Nonmydriatic fundus photograph. NIDEK AFC-230. CFP
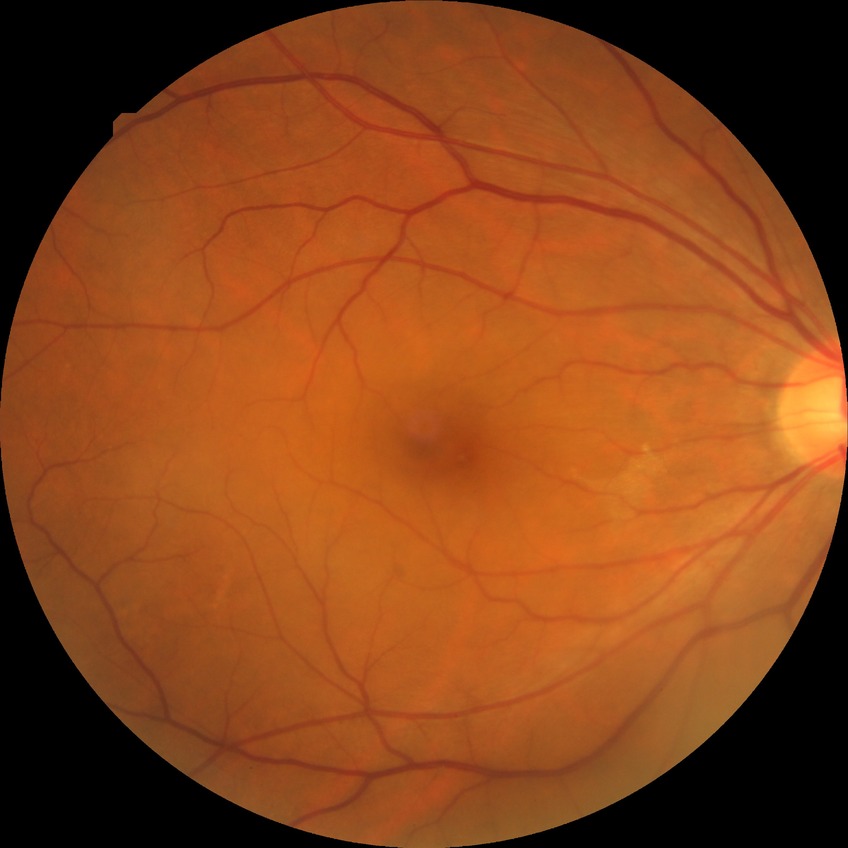 modified Davis grading: no diabetic retinopathy.